Wide-field fundus photograph from neonatal ROP screening — 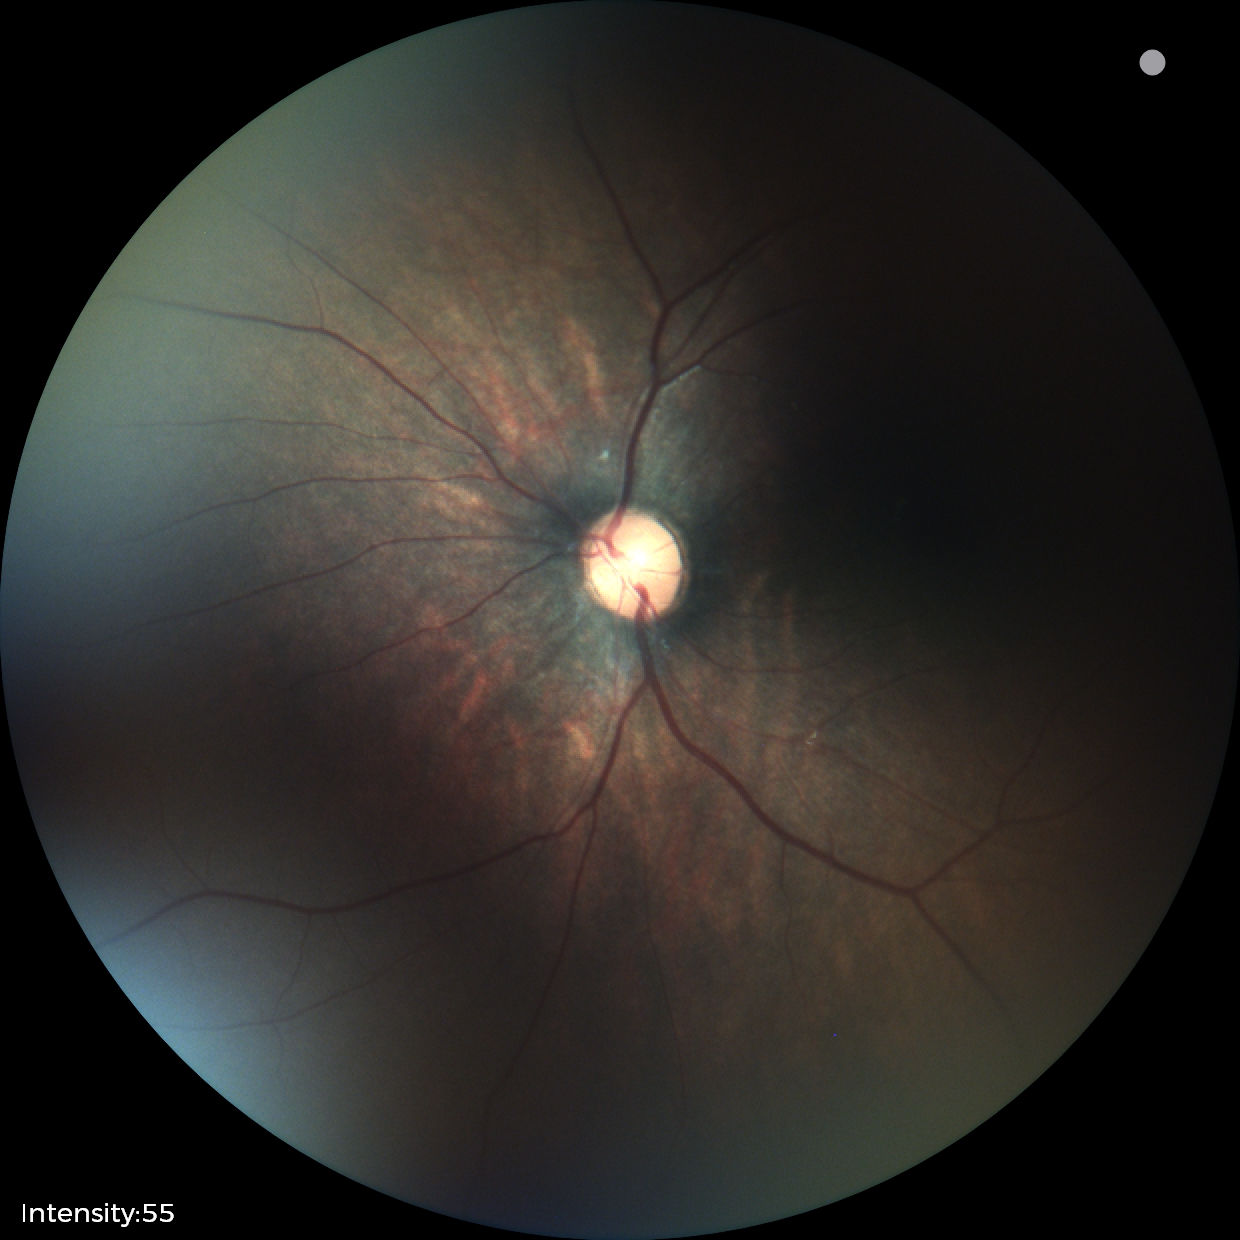
Examination with physiological retinal findings.